45° field of view
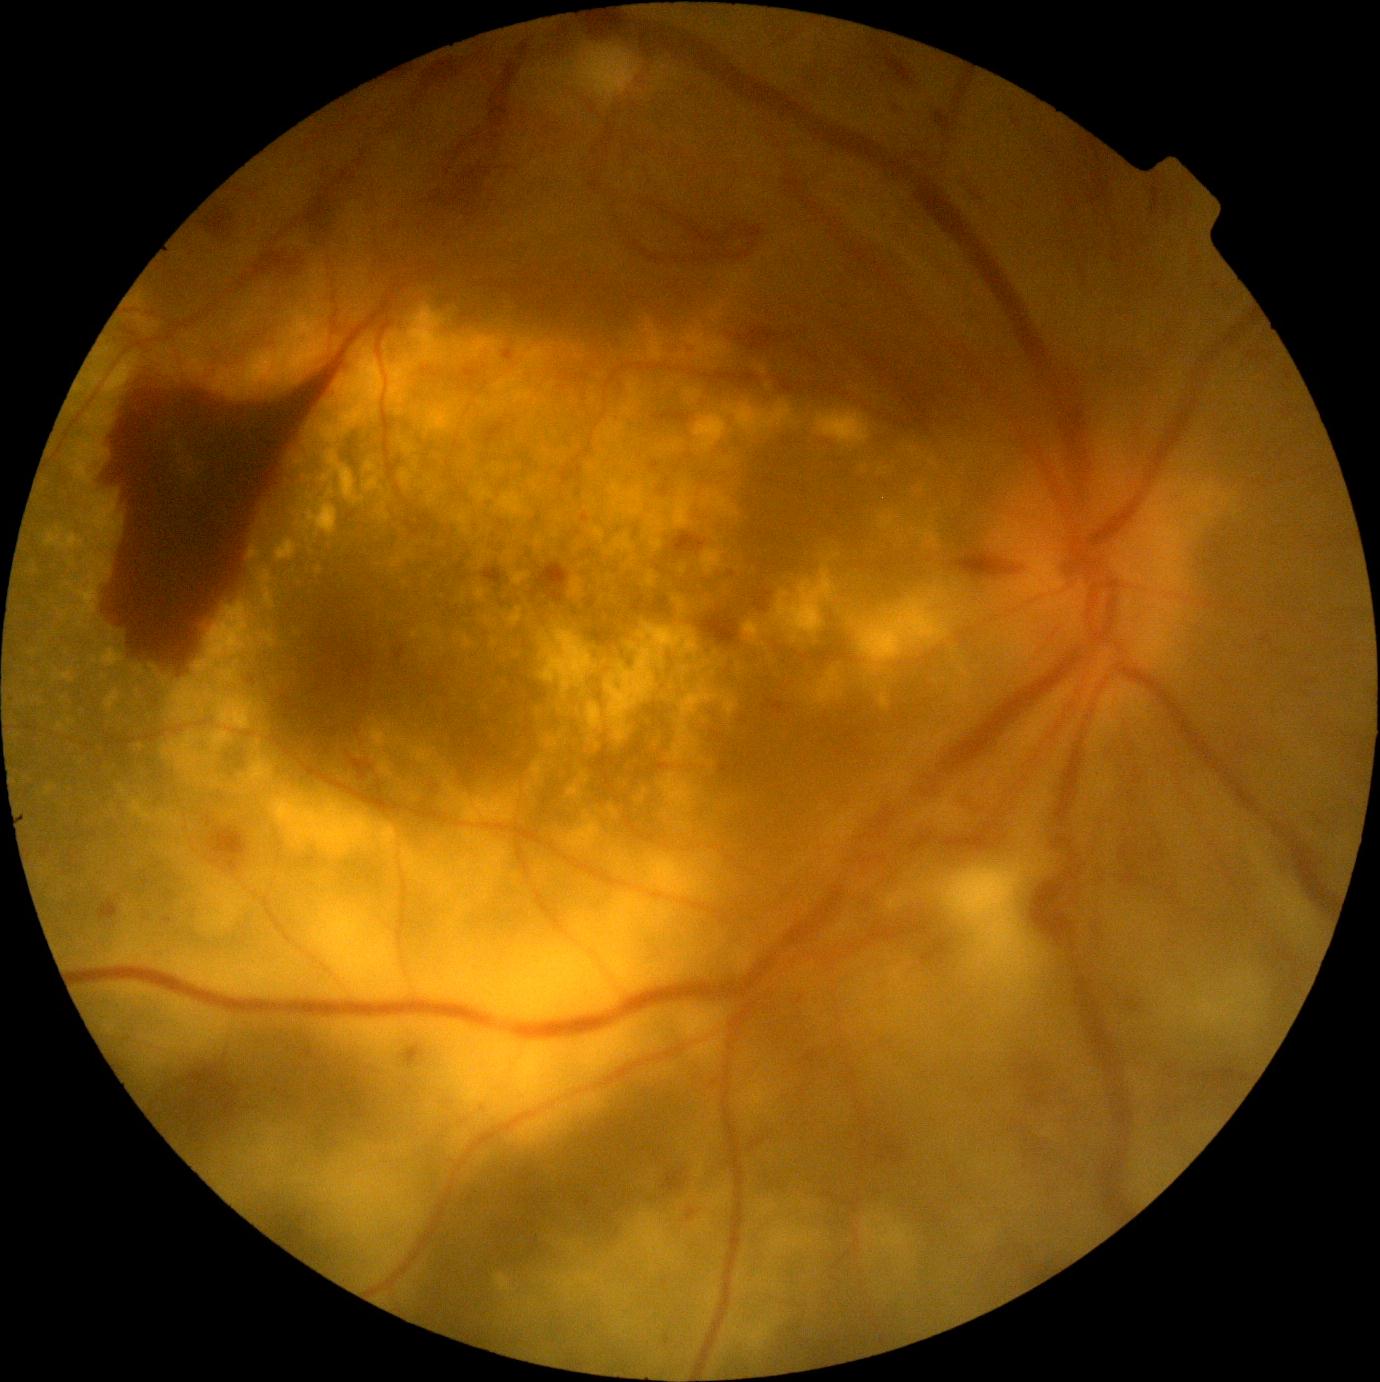 DR grade is 4/4.